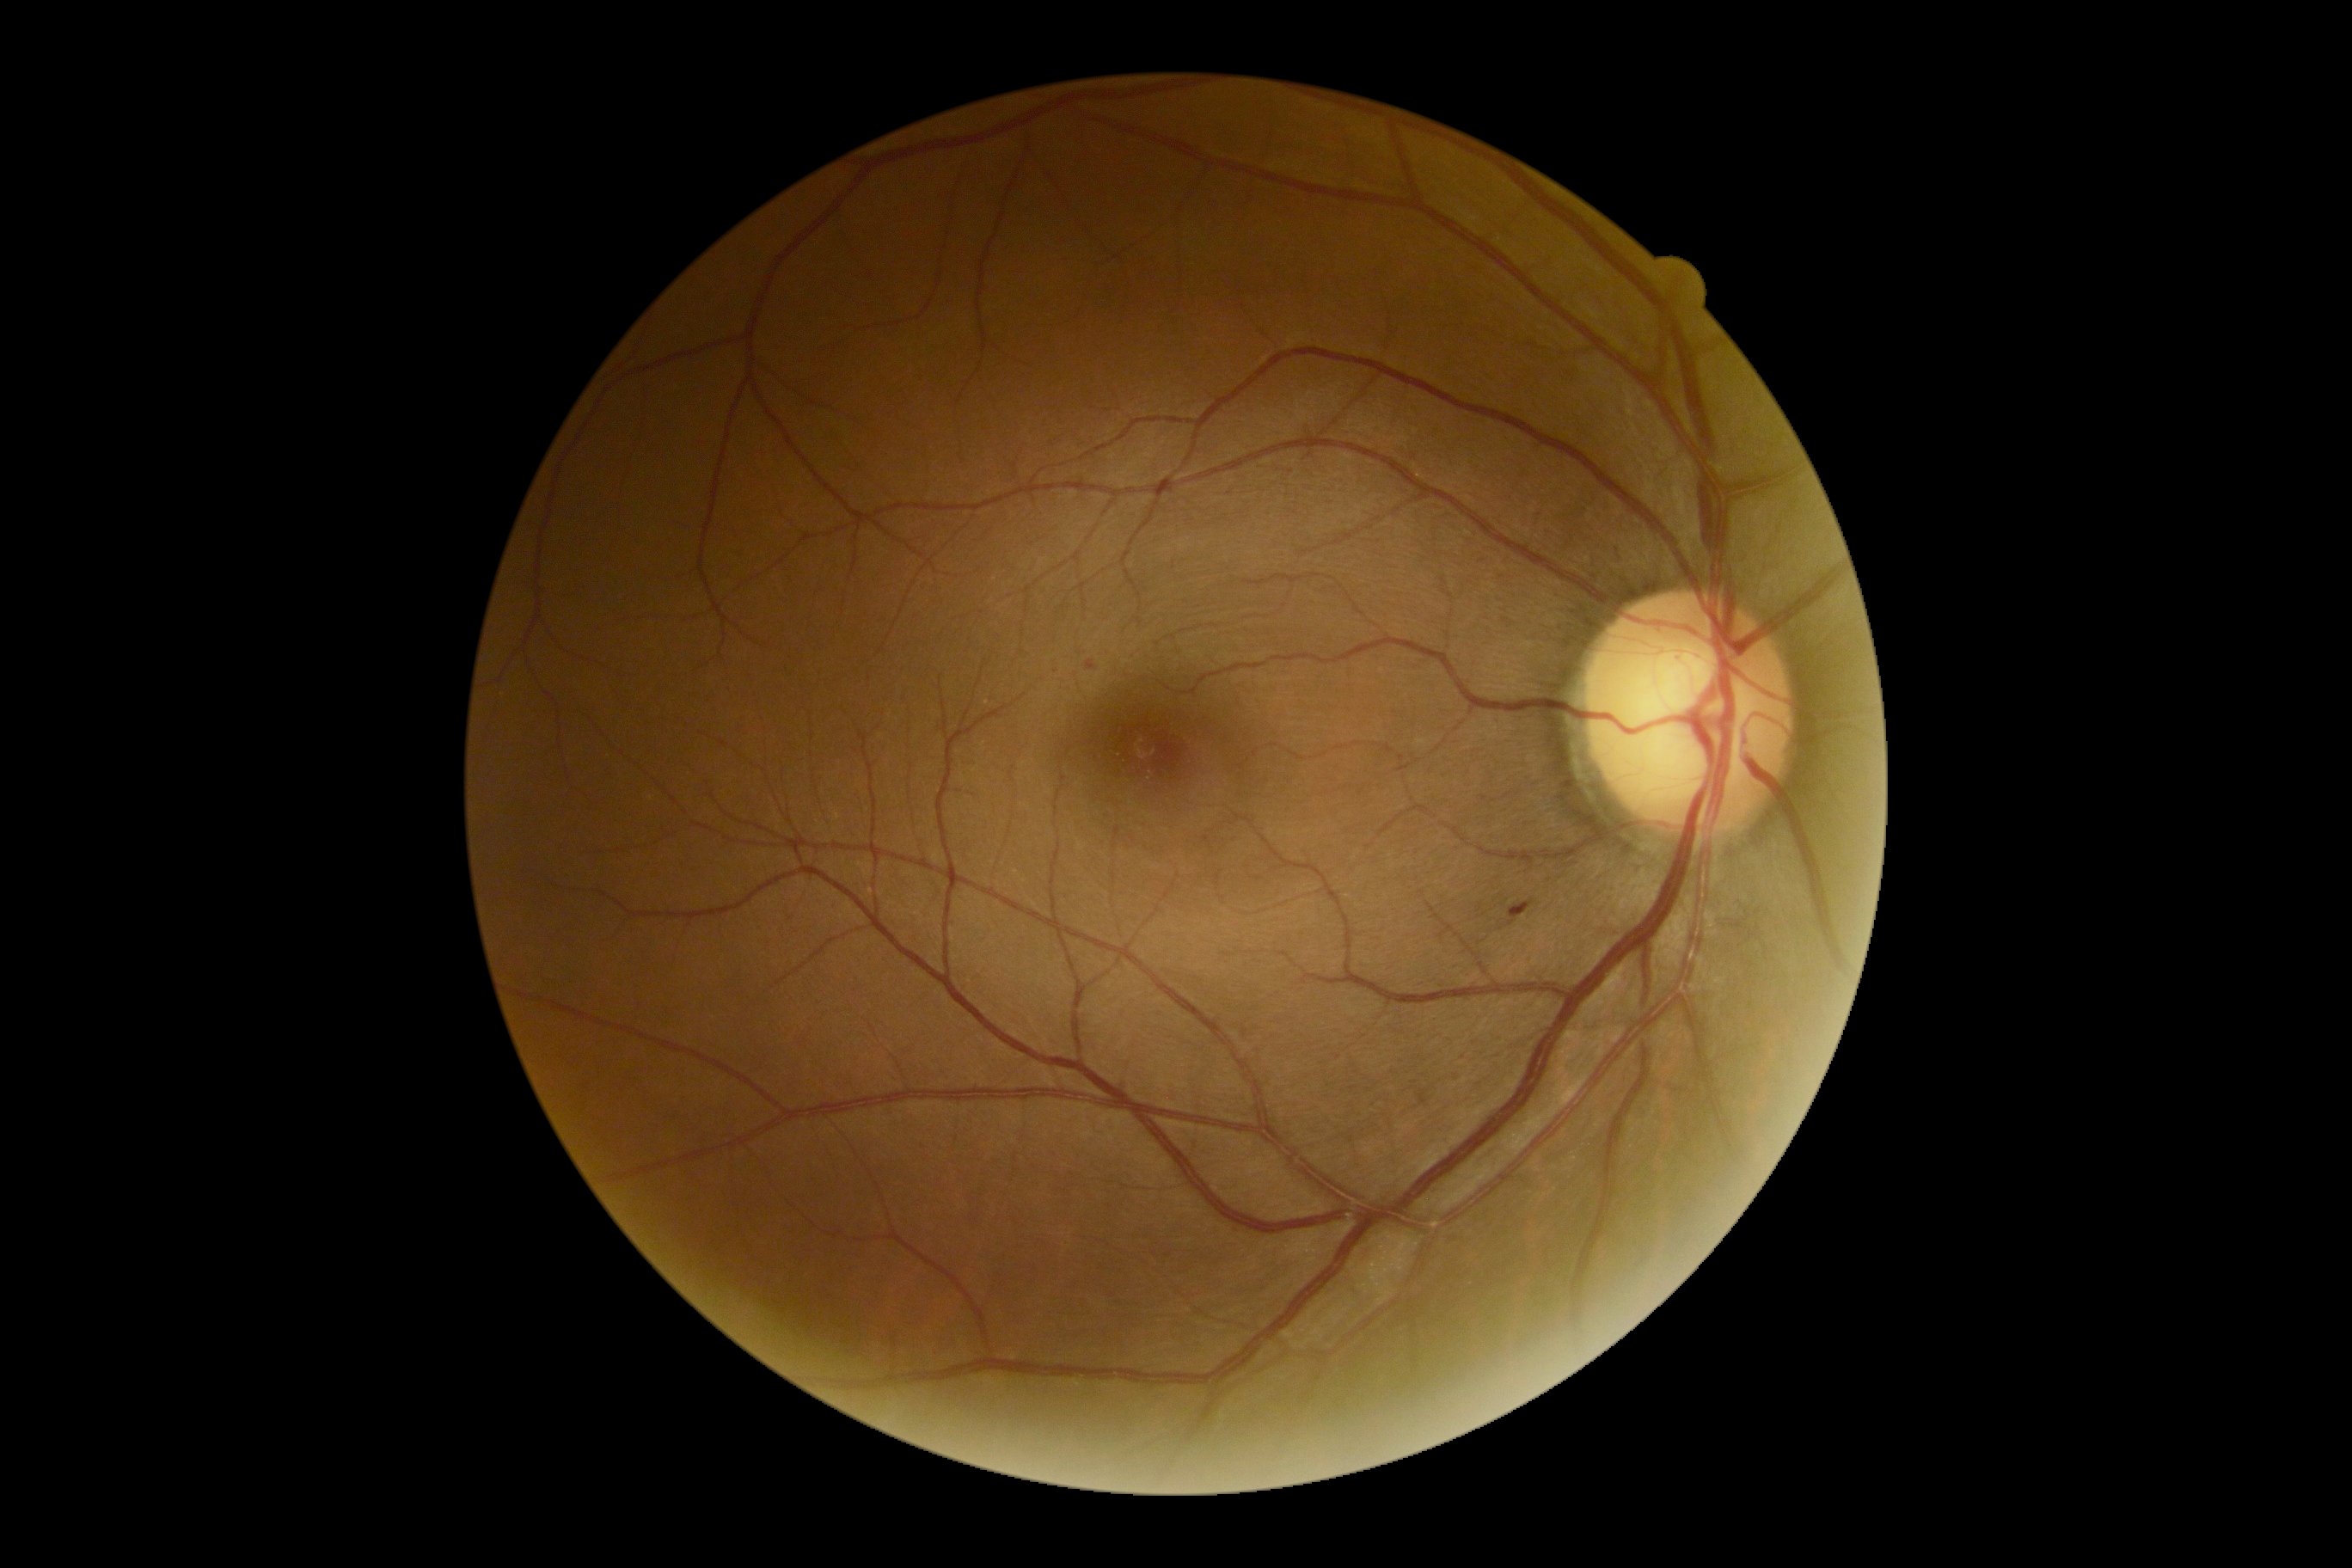
DR stage: grade 2.